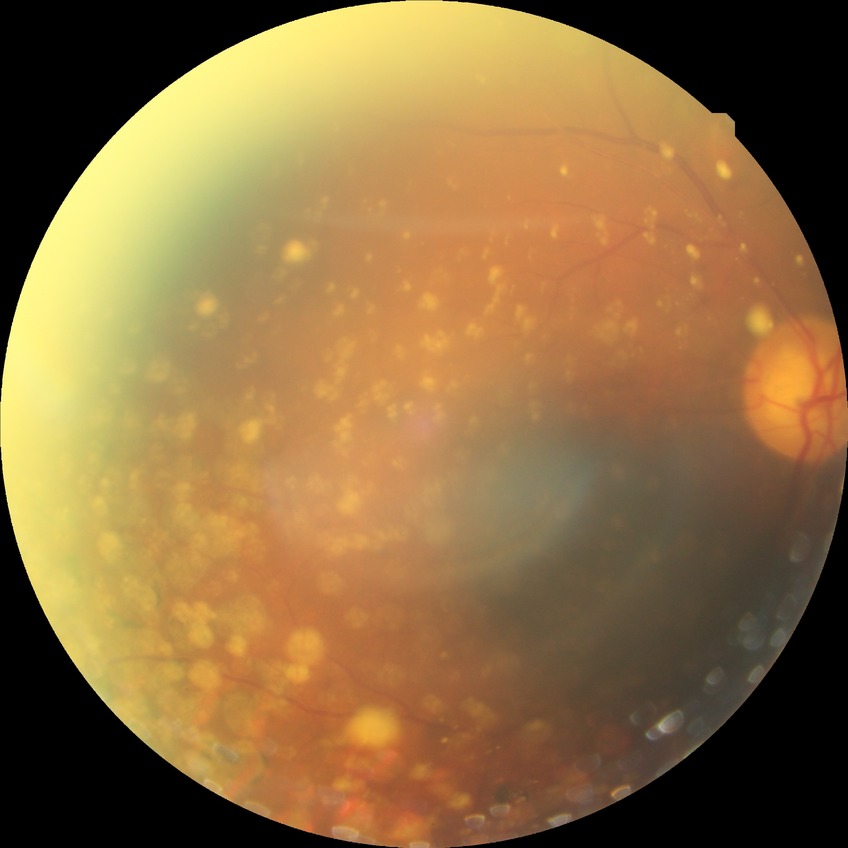 DR grade: PDR